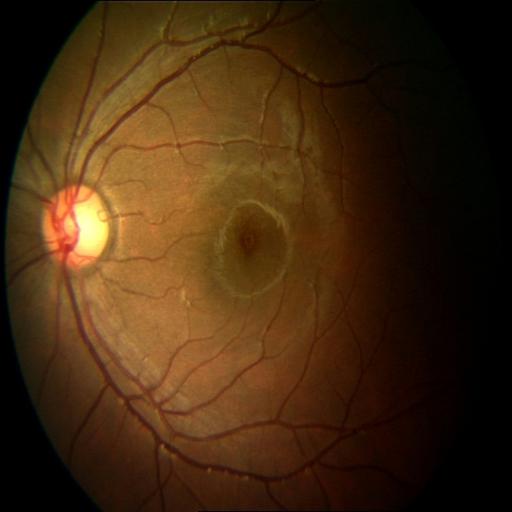 Abnormalities:
- central serous retinopathy (CSR)